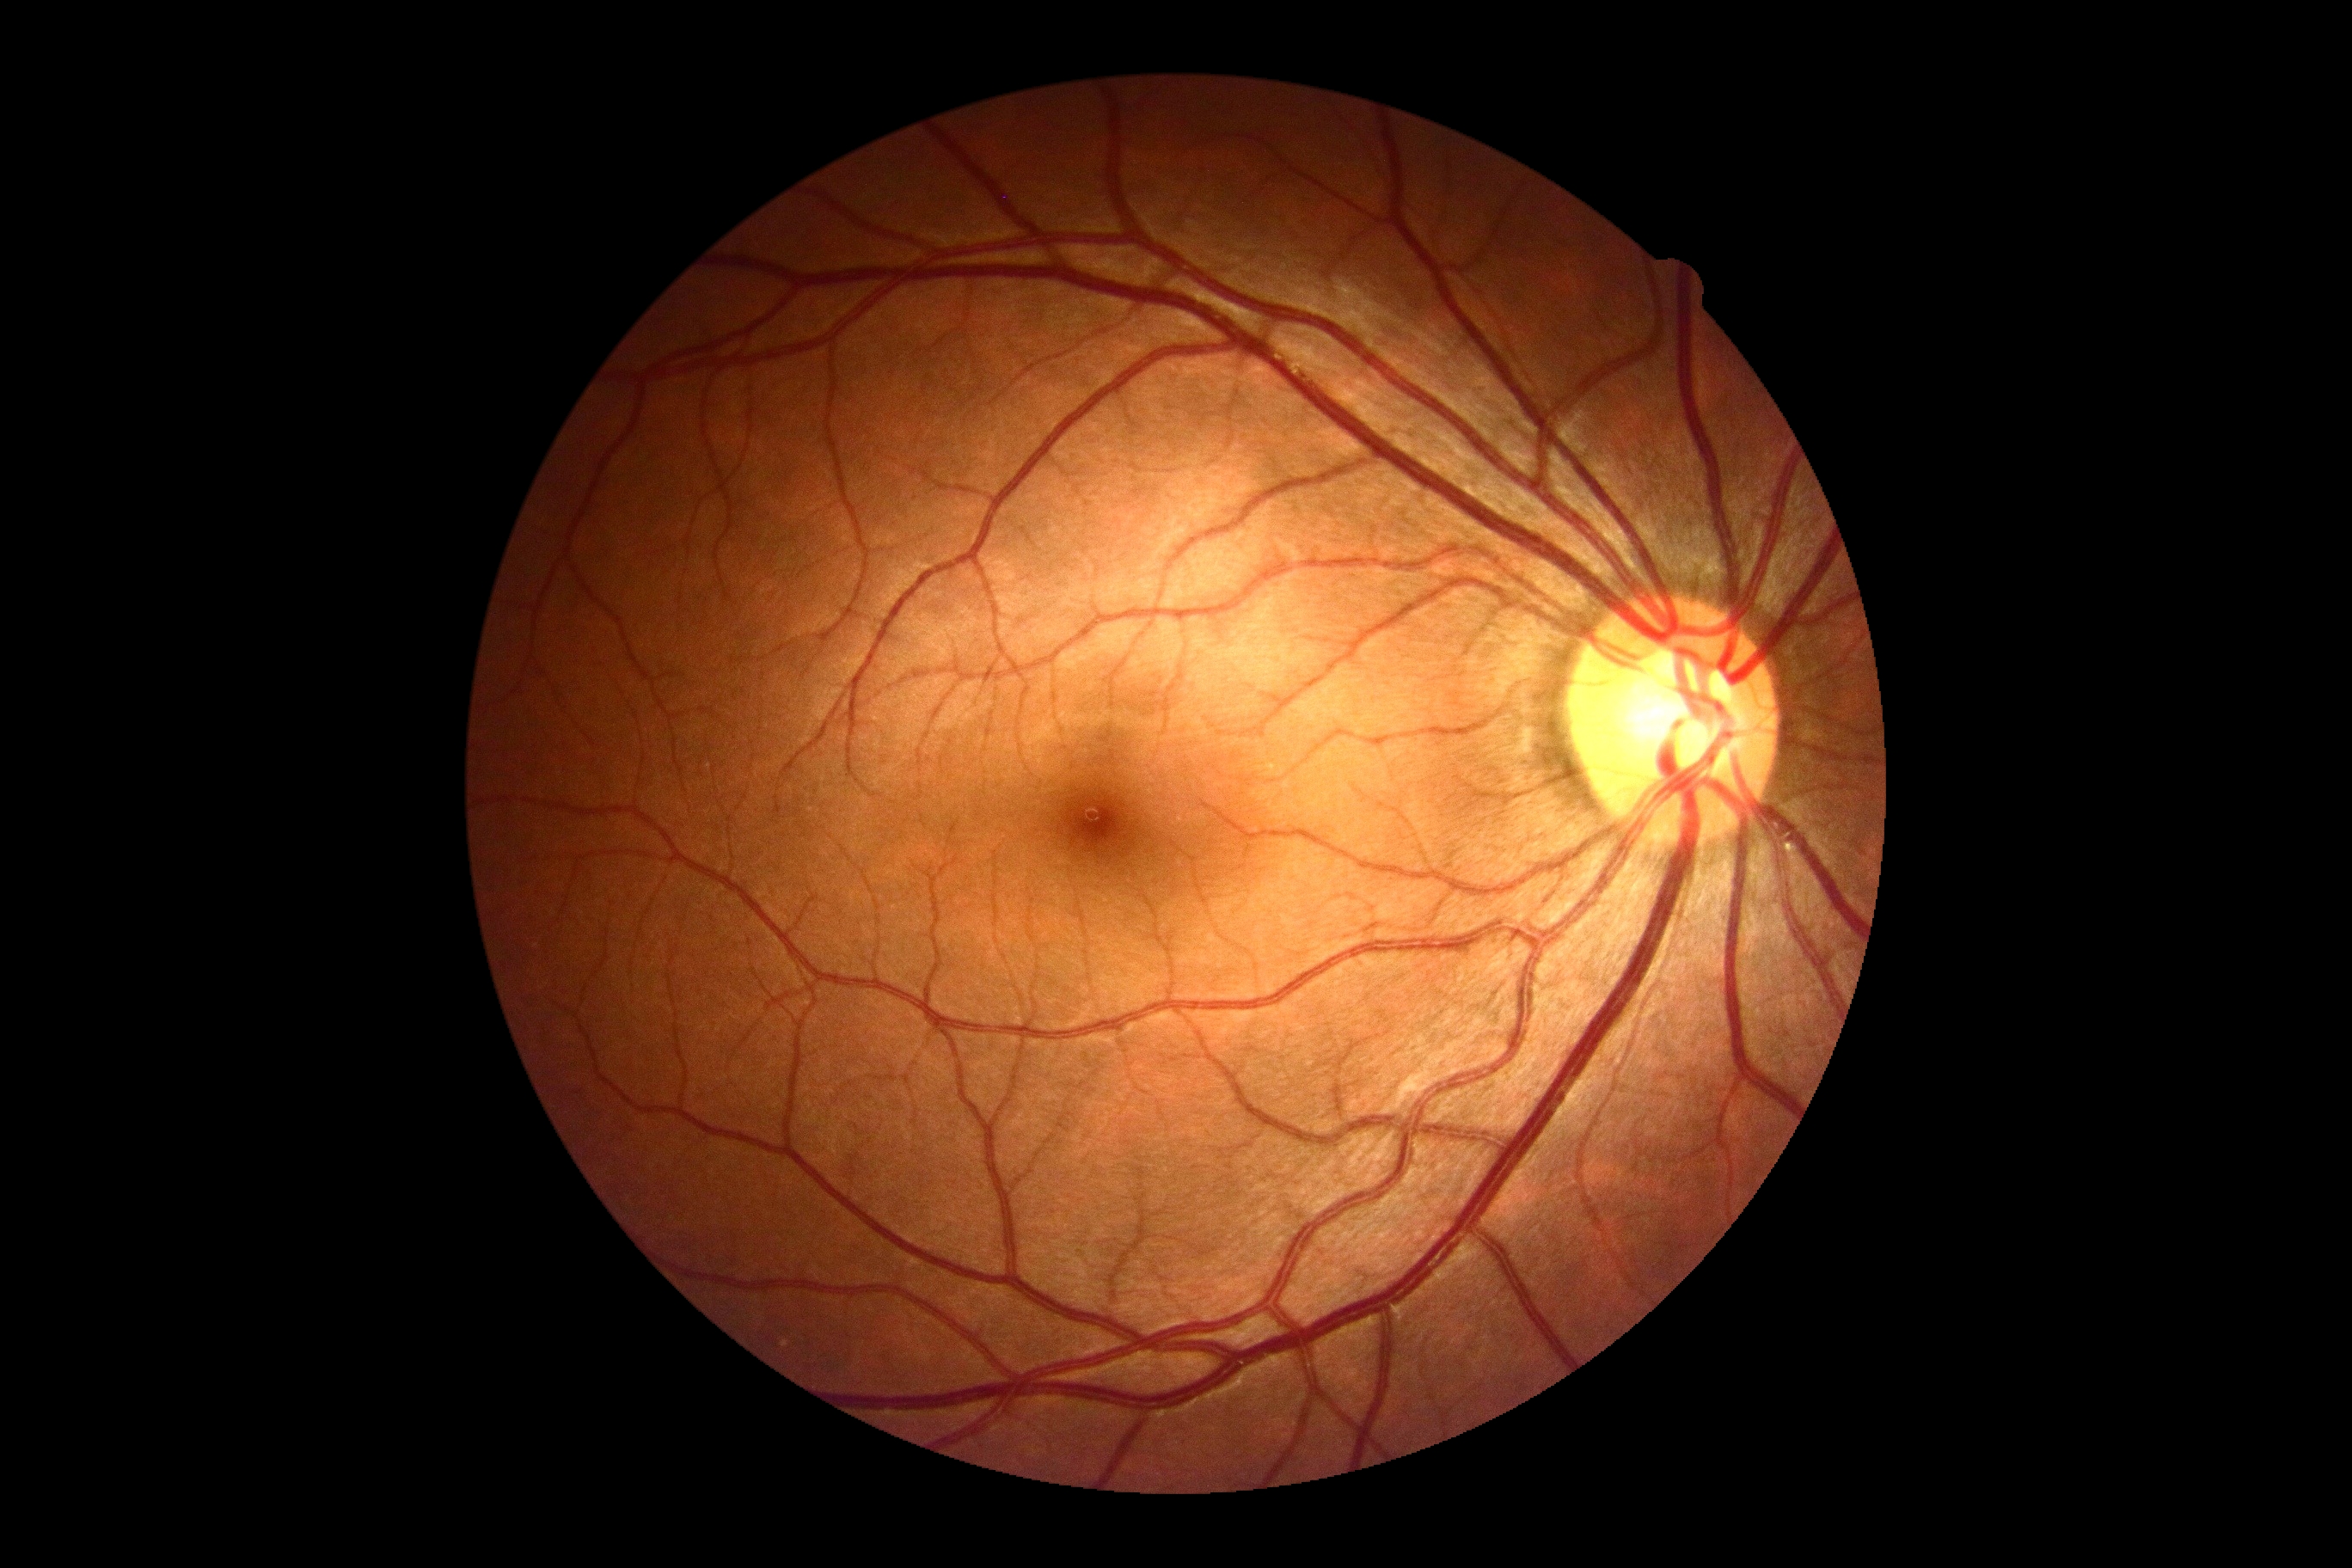

DR severity: grade 0.